CFP:
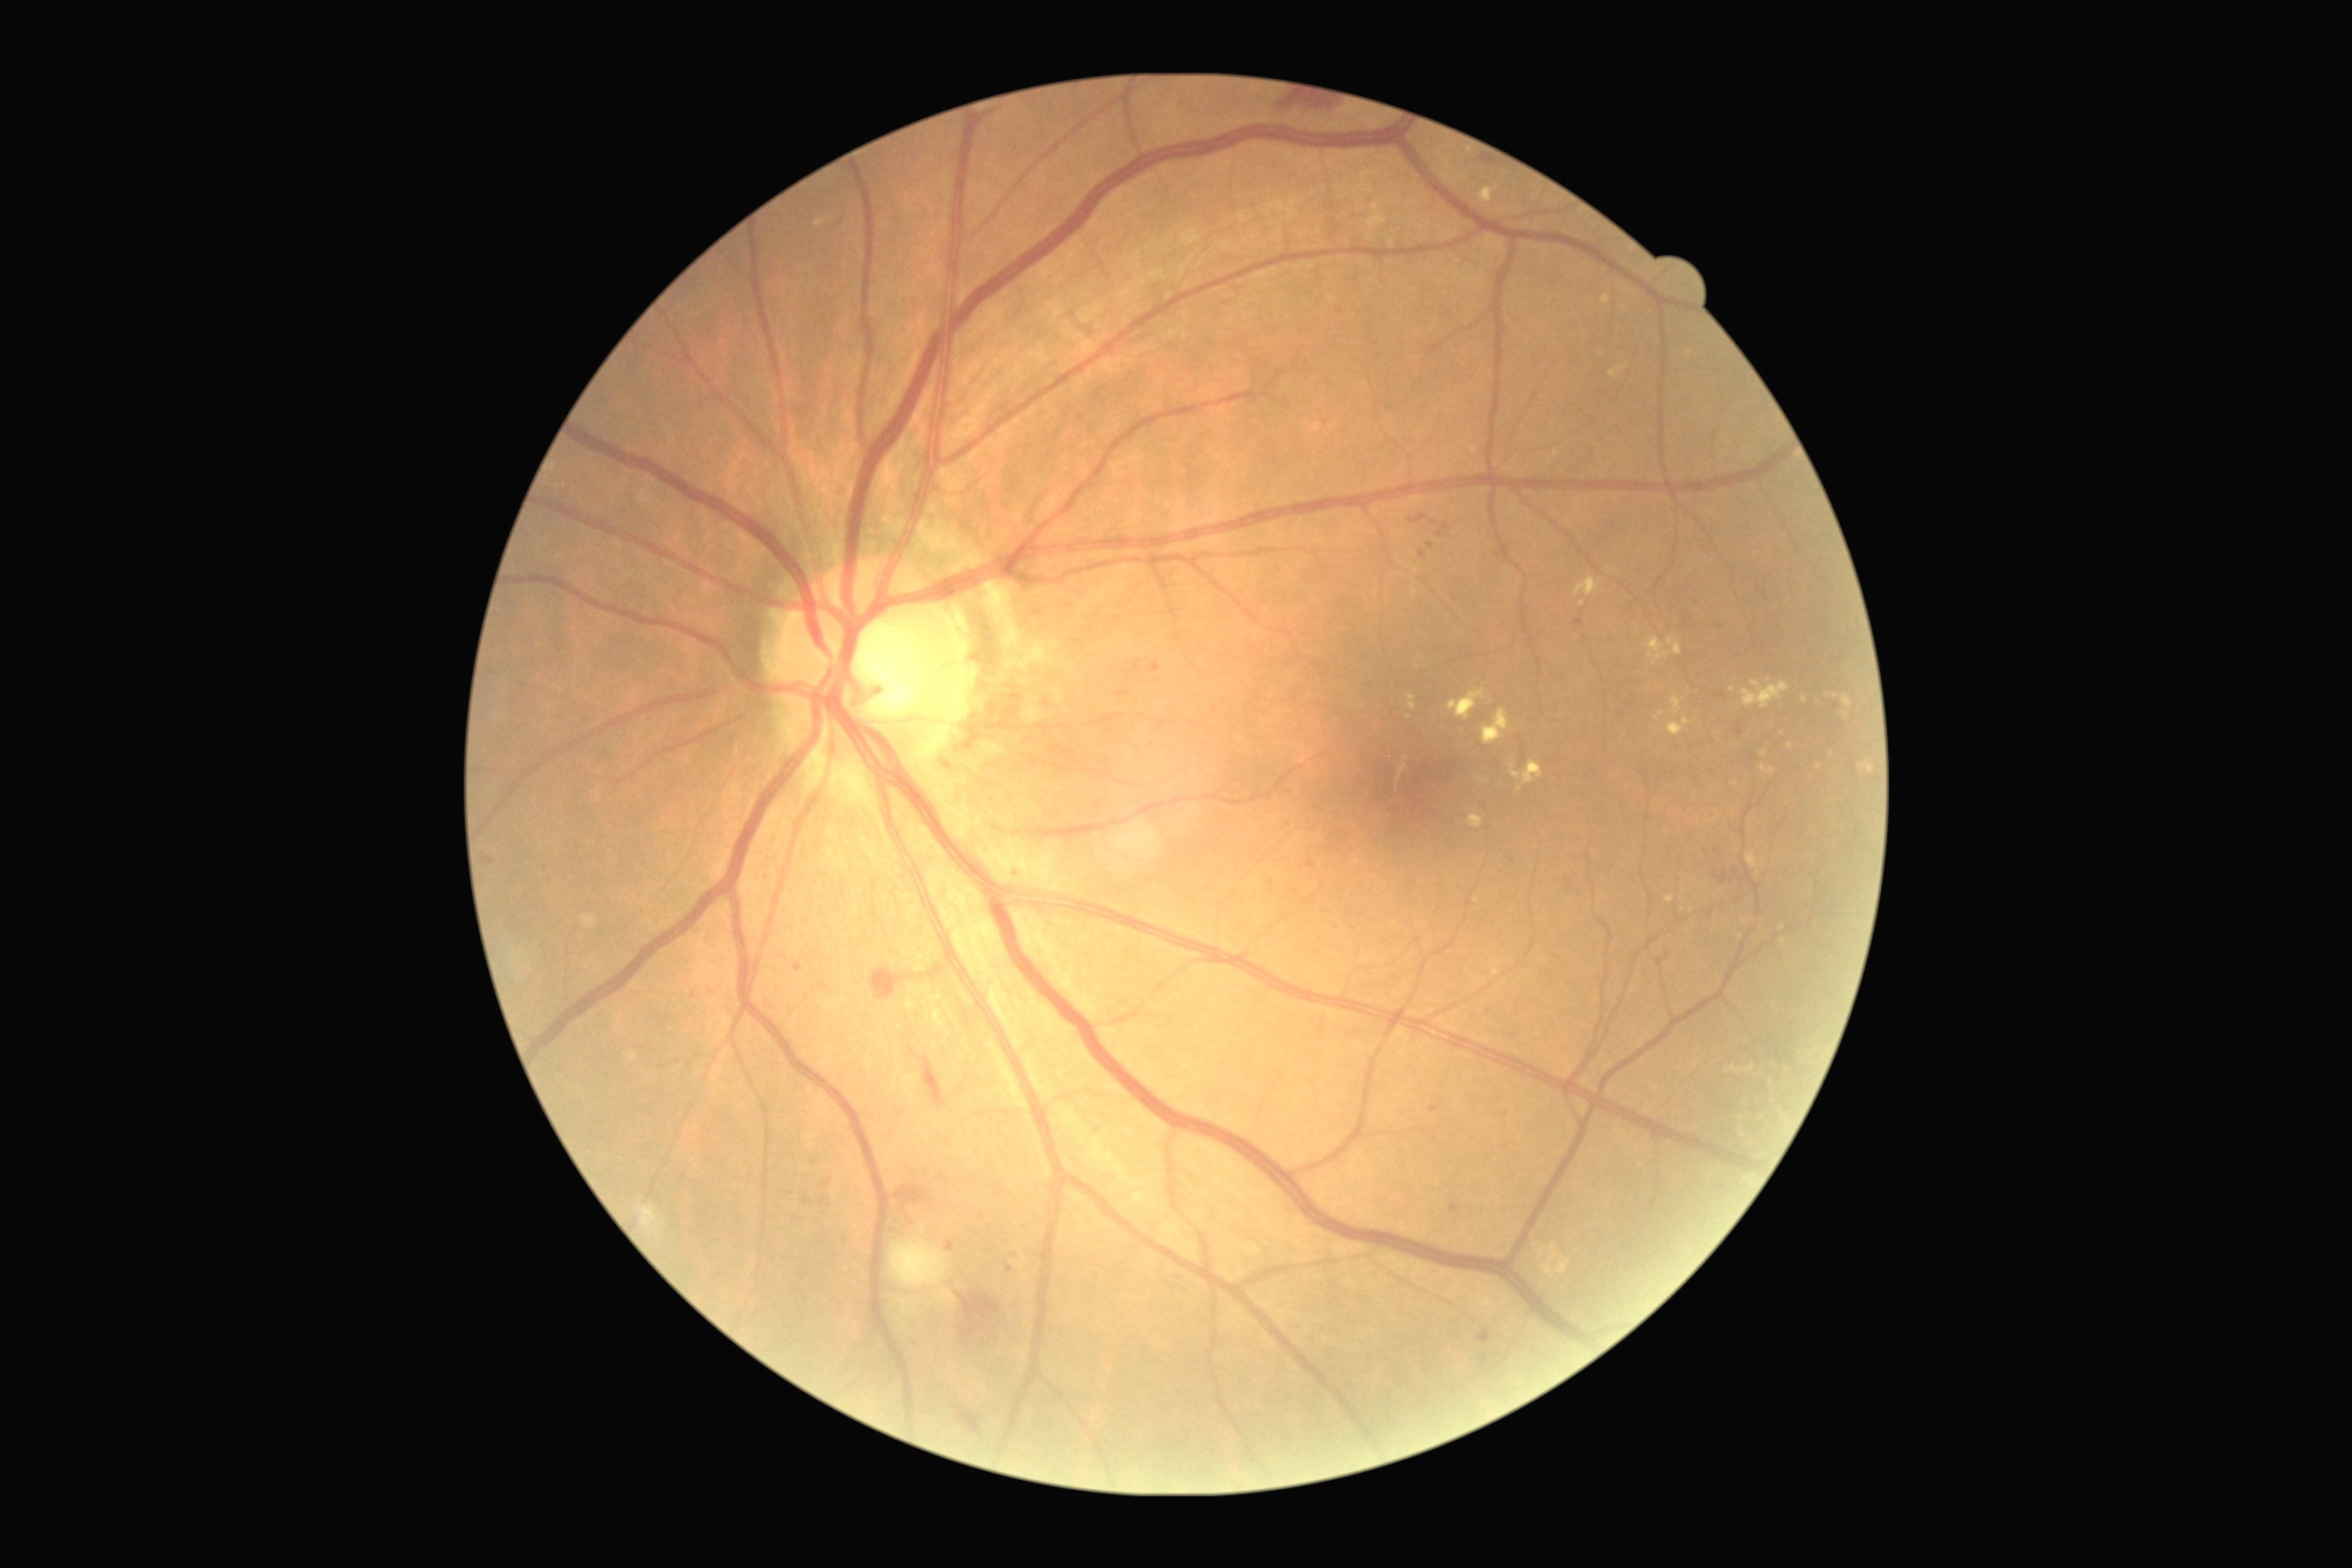
Diabetic retinopathy (DR) is grade 2
Selected lesions:
hard exudates (EXs) (subset): [left=1469, top=814, right=1485, bottom=828] | [left=1656, top=710, right=1665, bottom=721] | [left=1667, top=718, right=1694, bottom=736] | [left=1511, top=760, right=1544, bottom=785] | [left=1478, top=186, right=1498, bottom=204] | [left=1672, top=698, right=1681, bottom=714] | [left=1447, top=689, right=1487, bottom=721]
Small EXs near (1582, 604) | (1521, 790) | (1483, 783)
microaneurysms (MAs) (subset): [left=1117, top=692, right=1128, bottom=698] | [left=1716, top=872, right=1727, bottom=885] | [left=1436, top=525, right=1451, bottom=538] | [left=794, top=965, right=803, bottom=974] | [left=805, top=1197, right=810, bottom=1206] | [left=1006, top=1264, right=1014, bottom=1273] | [left=1427, top=544, right=1435, bottom=549] | [left=1574, top=620, right=1583, bottom=627] | [left=701, top=988, right=714, bottom=999] | [left=1150, top=663, right=1161, bottom=672]
Small MAs near (813, 1163) | (1423, 554) | (1489, 1012) | (1017, 870)